1504 by 1000 pixels:
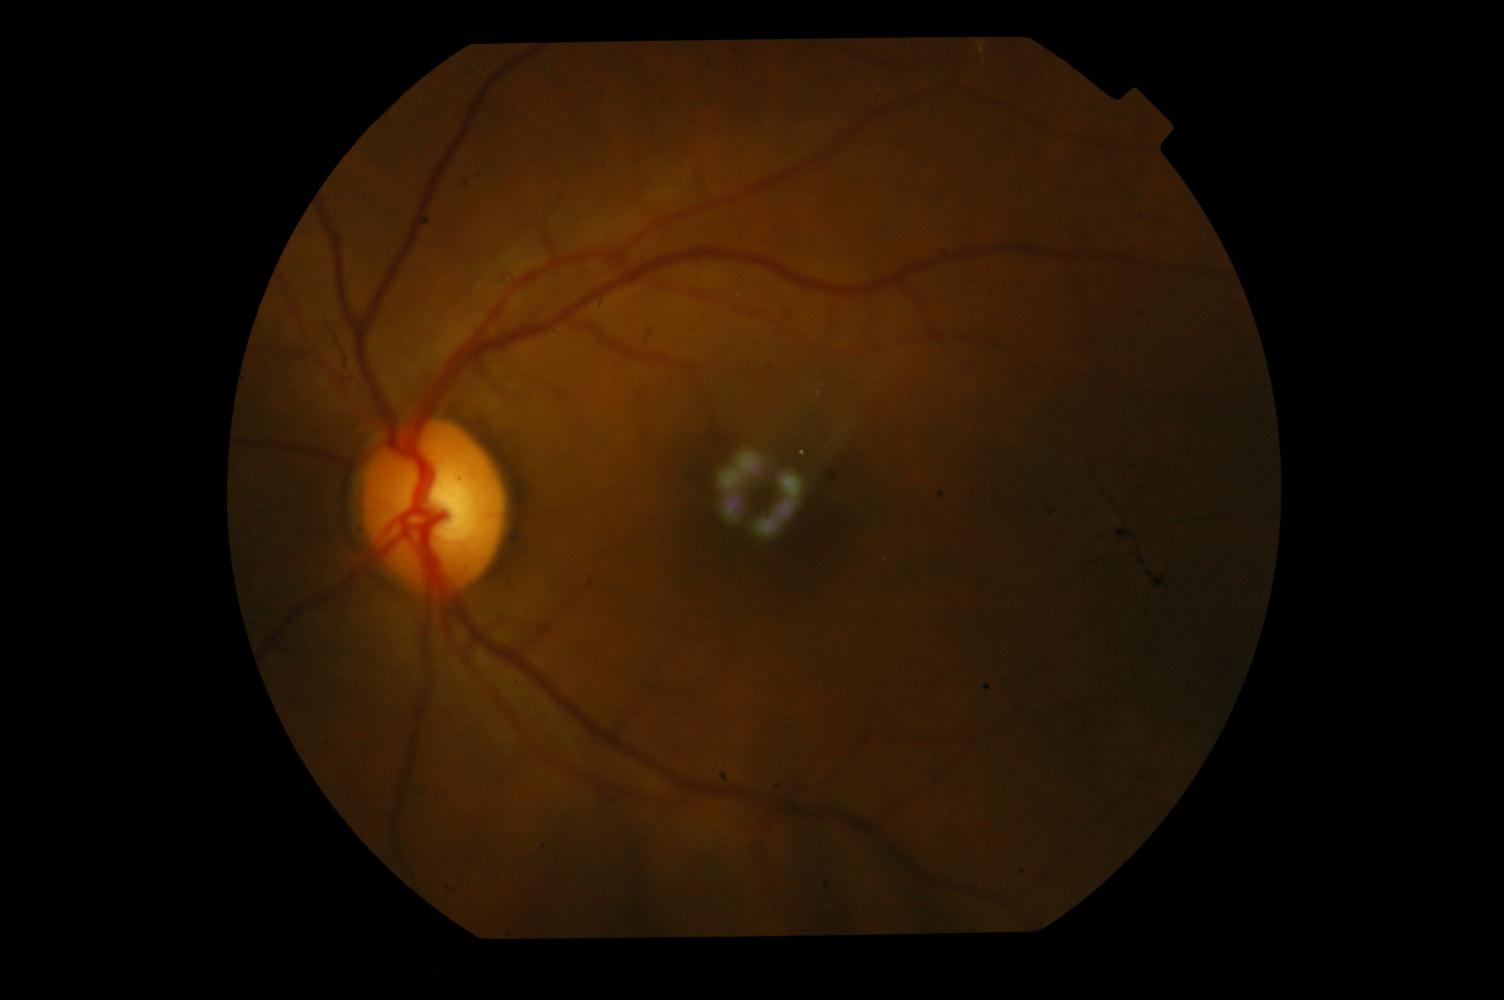
Diagnosis: branch retinal vein occlusion.